Infant wide-field fundus photograph. 640 x 480 pixels
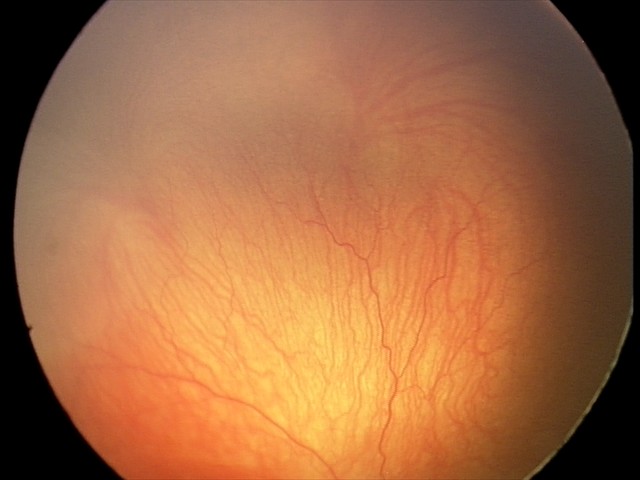 Impression: plus disease; aggressive retinopathy of prematurity (A-ROP).